848x848px; NIDEK AFC-230 fundus camera; nonmydriatic fundus photograph; posterior pole photograph; diabetic retinopathy graded by the modified Davis classification:
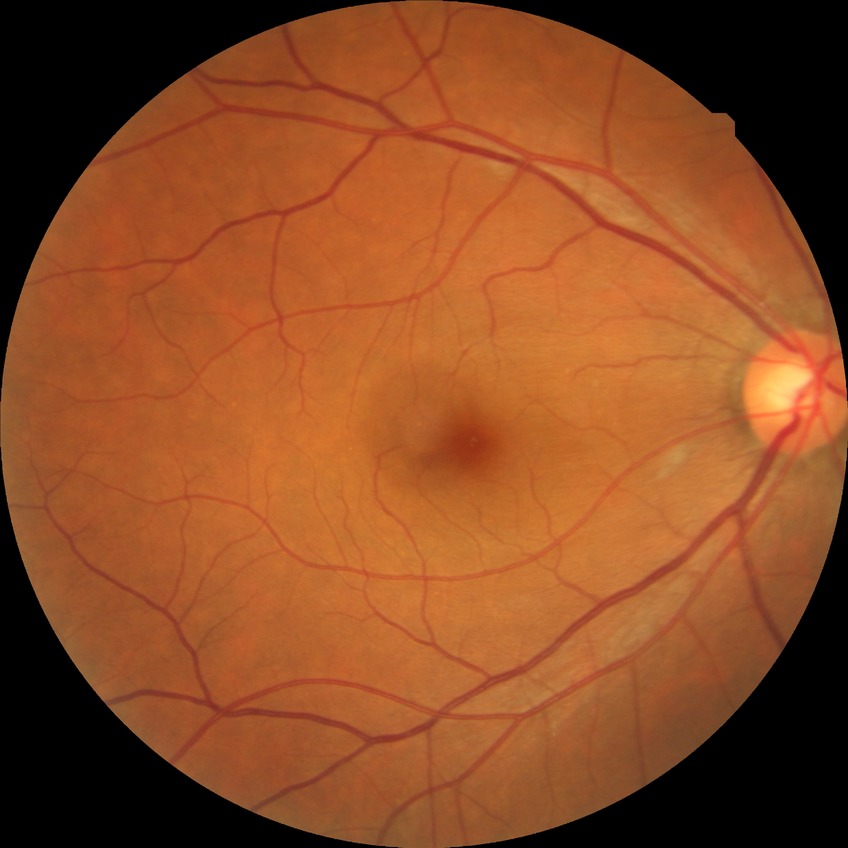

Assessment:
- diabetic retinopathy stage — no diabetic retinopathy